Pediatric wide-field fundus photograph — 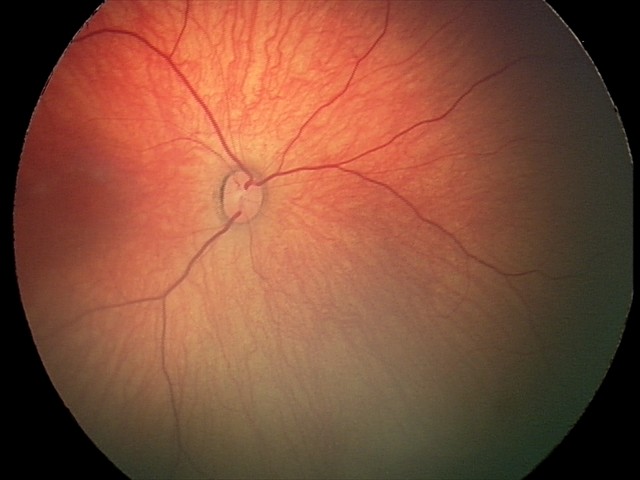 Screening: retinal hemorrhages.